Camera: NIDEK AFC-230. Color fundus photograph: 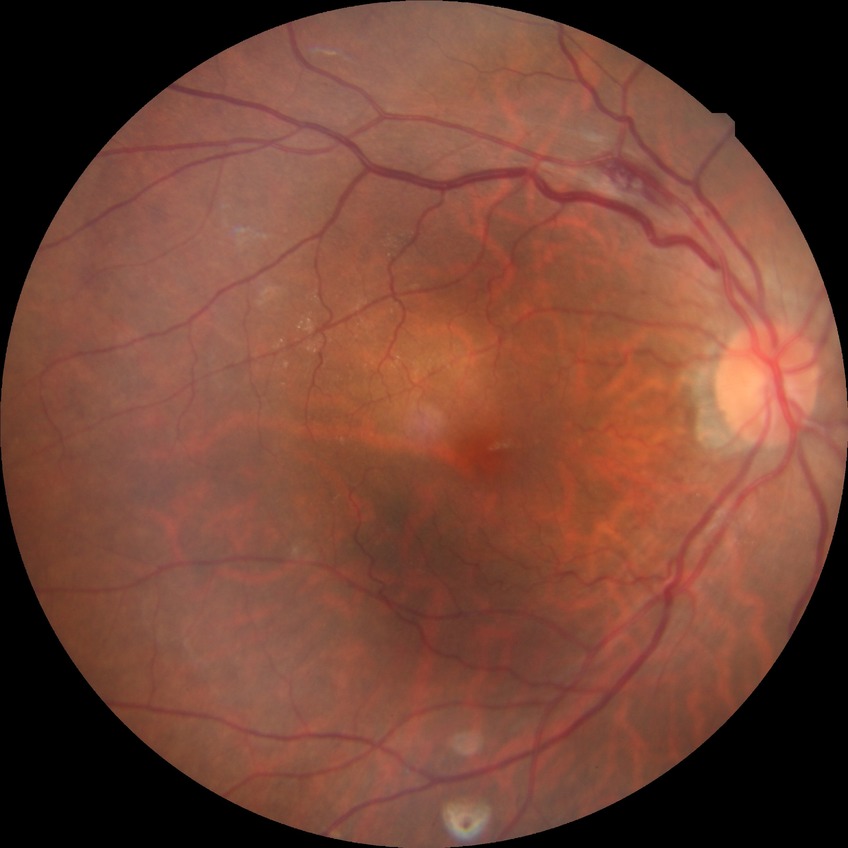
diabetic retinopathy (DR) = no diabetic retinopathy (NDR).